2048x1536px: 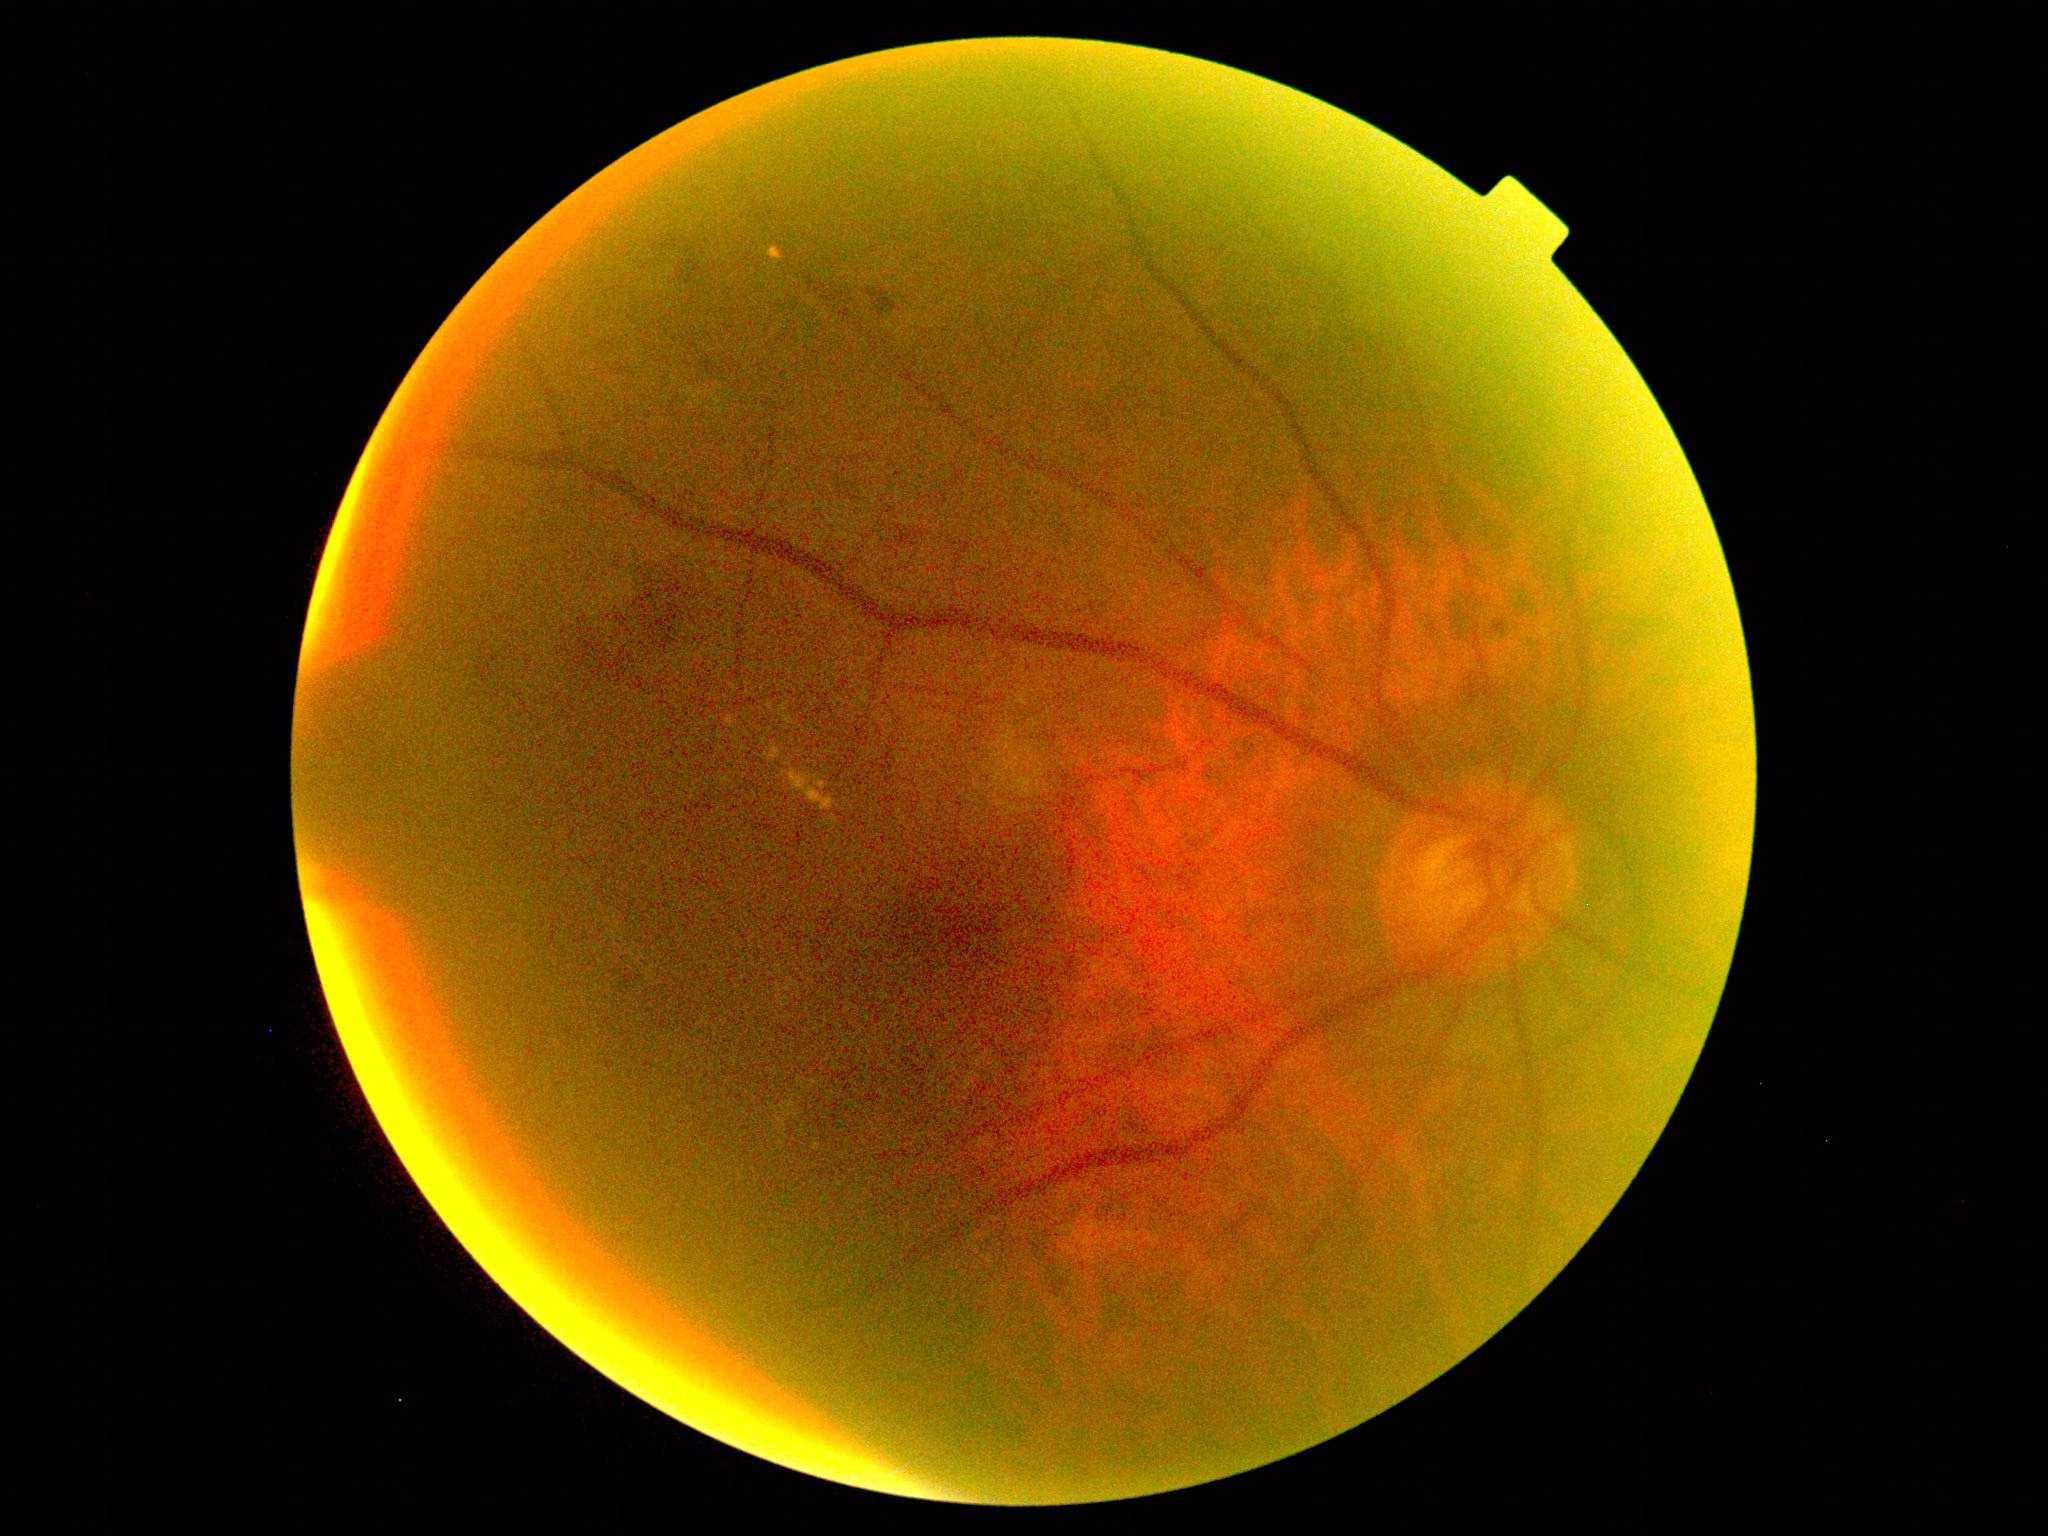 DR grade: 2/4.